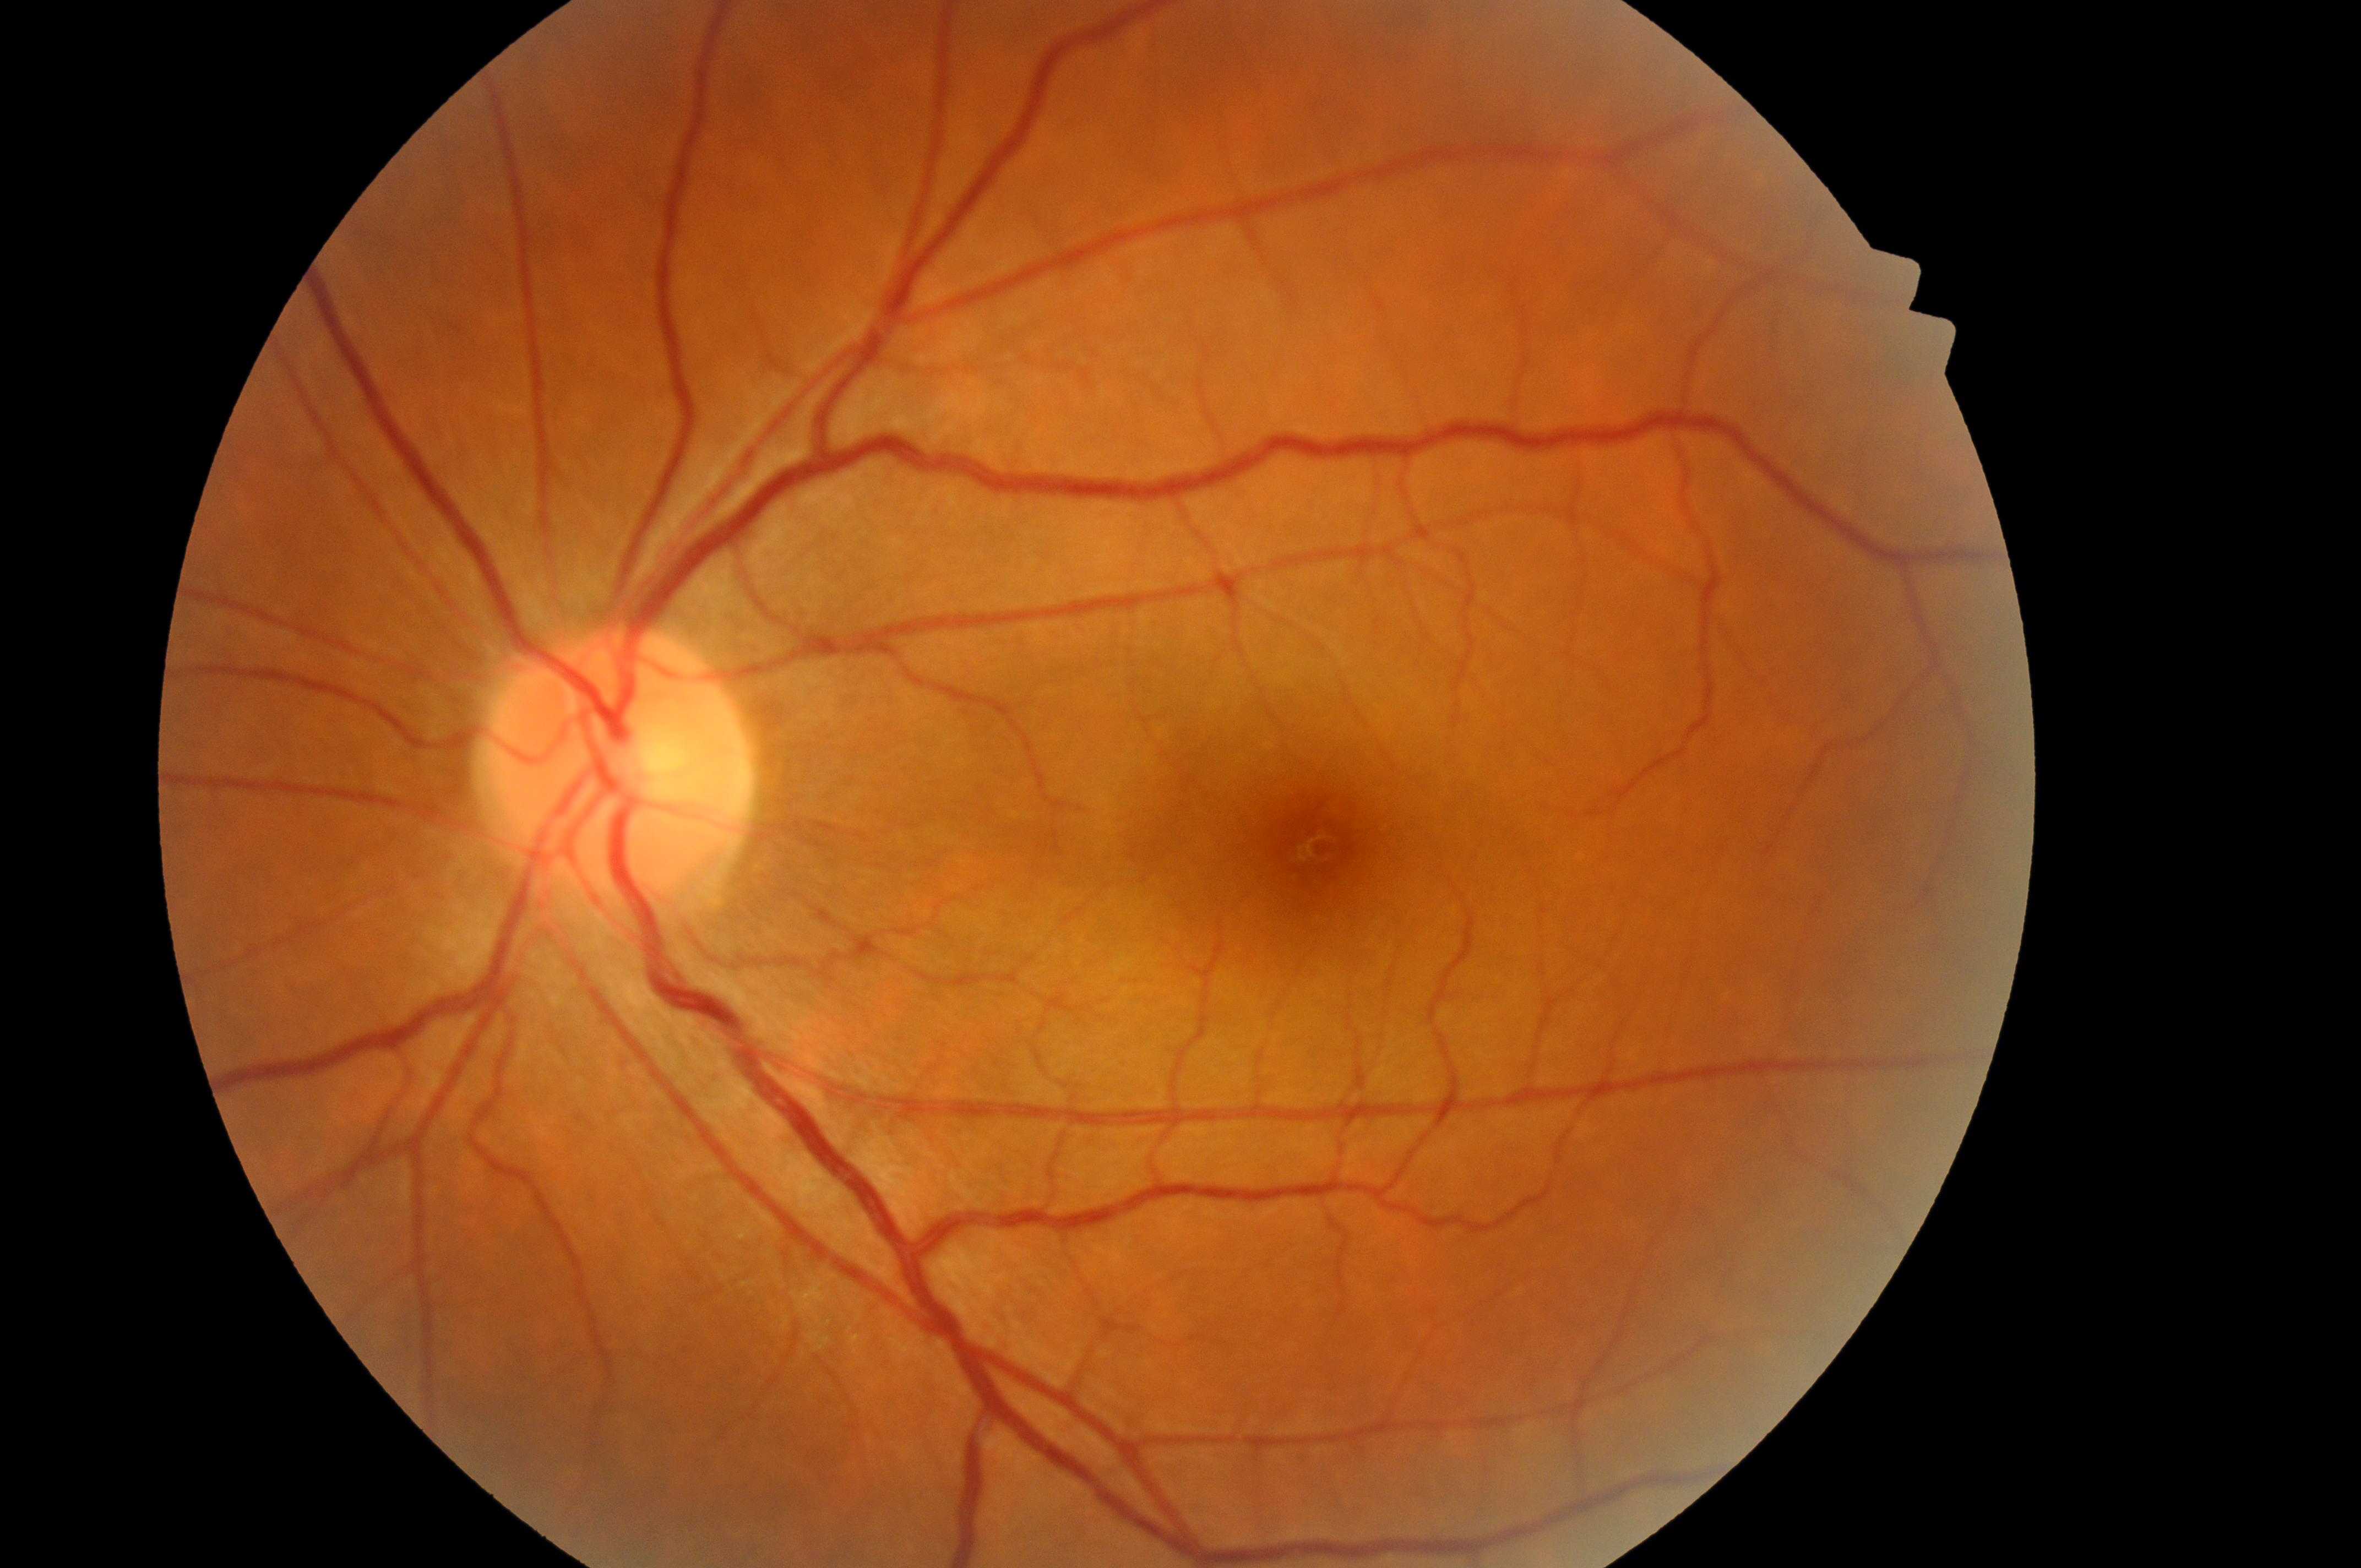
dme_grade: 0
fovea: (x: 1314, y: 850)
eye: left eye
dr_grade: 0/4
optic_disc: (x: 610, y: 783)